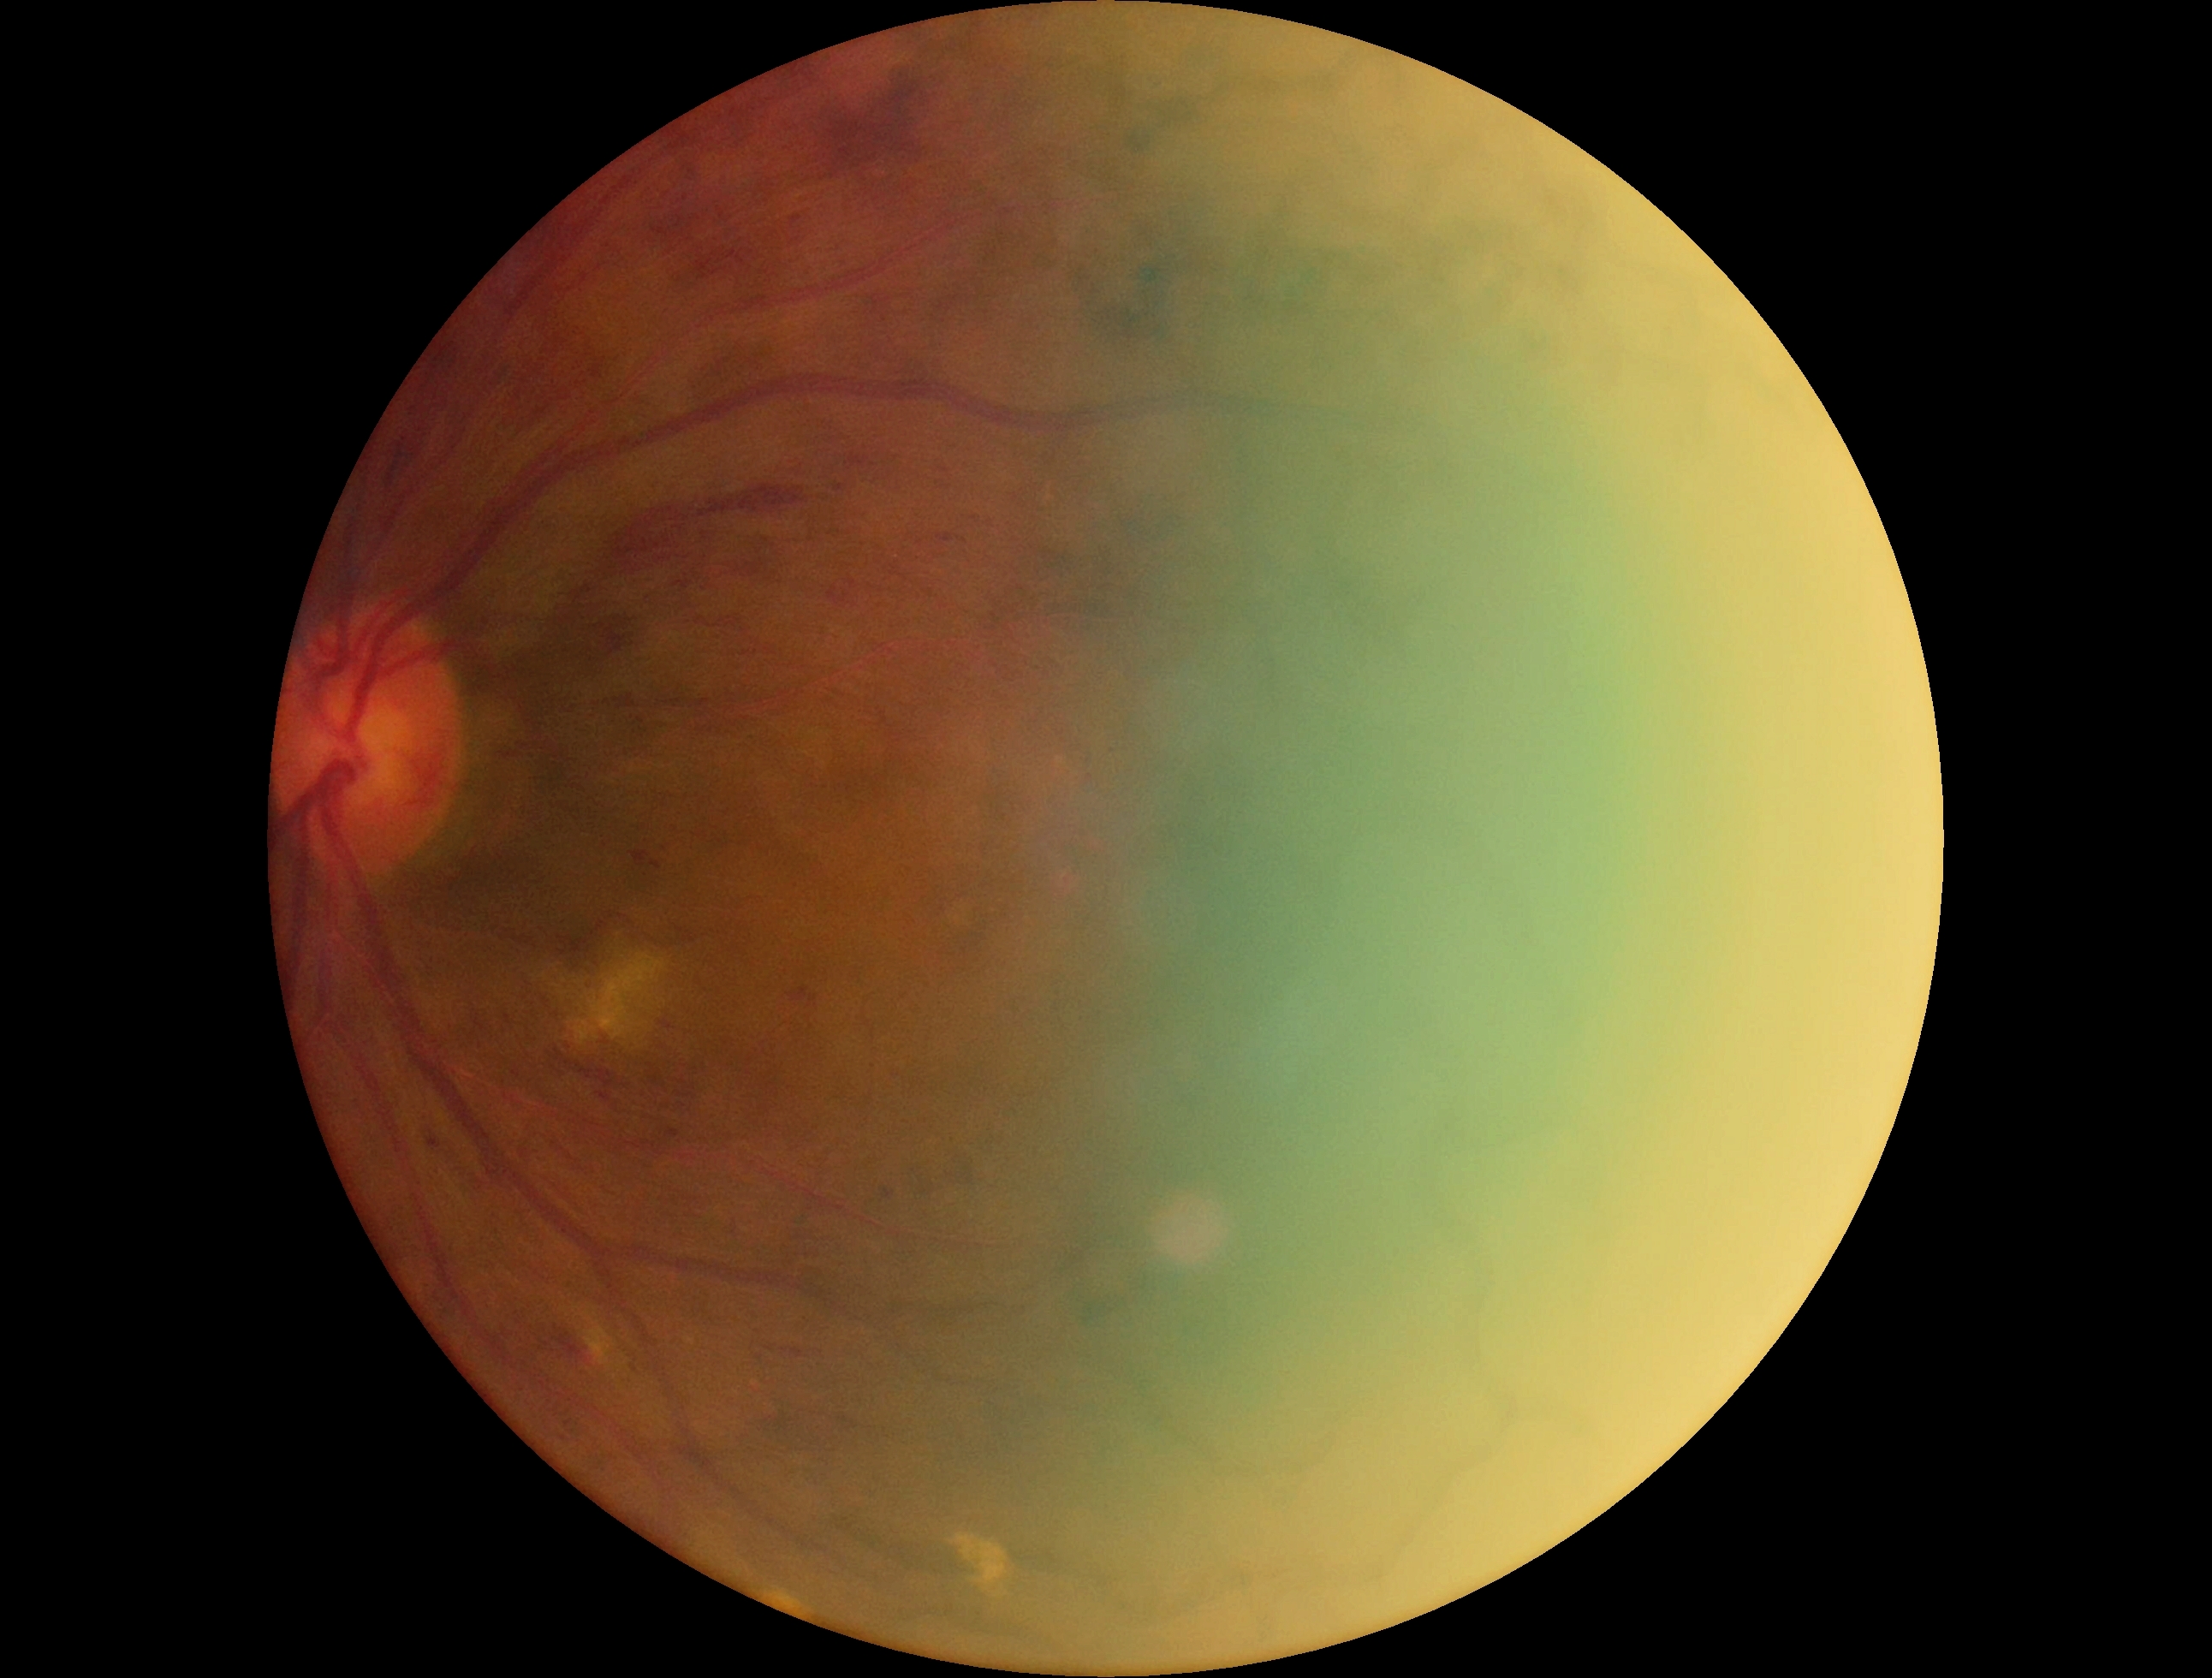
DR stage is grade 3 (severe NPDR).
DR class: non-proliferative diabetic retinopathy.